RetCam wide-field infant fundus image. 640 x 480 pixels: 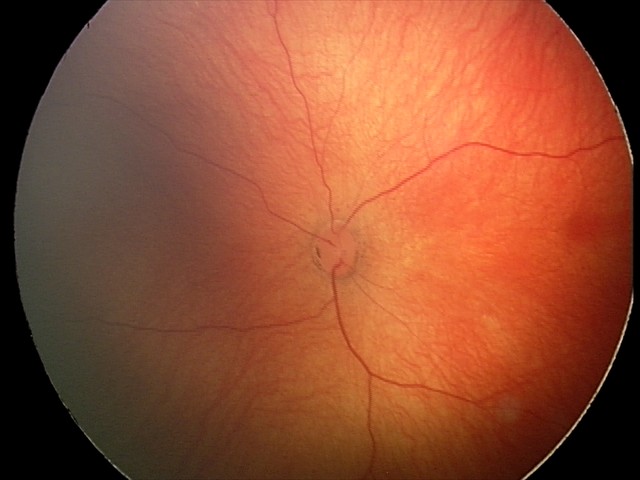
Examination with physiological retinal findings.